640x480; wide-field fundus image from infant ROP screening; camera: Clarity RetCam 3 (130° FOV) — 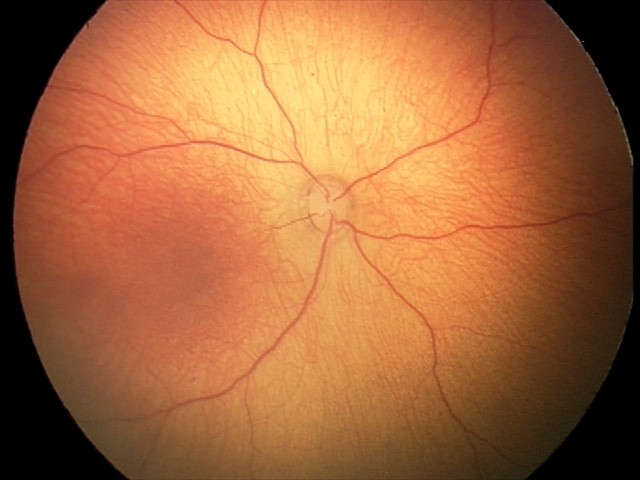

Physiological retinal appearance for postconceptual age.